Infant wide-field fundus photograph · 1240 by 1240 pixels: 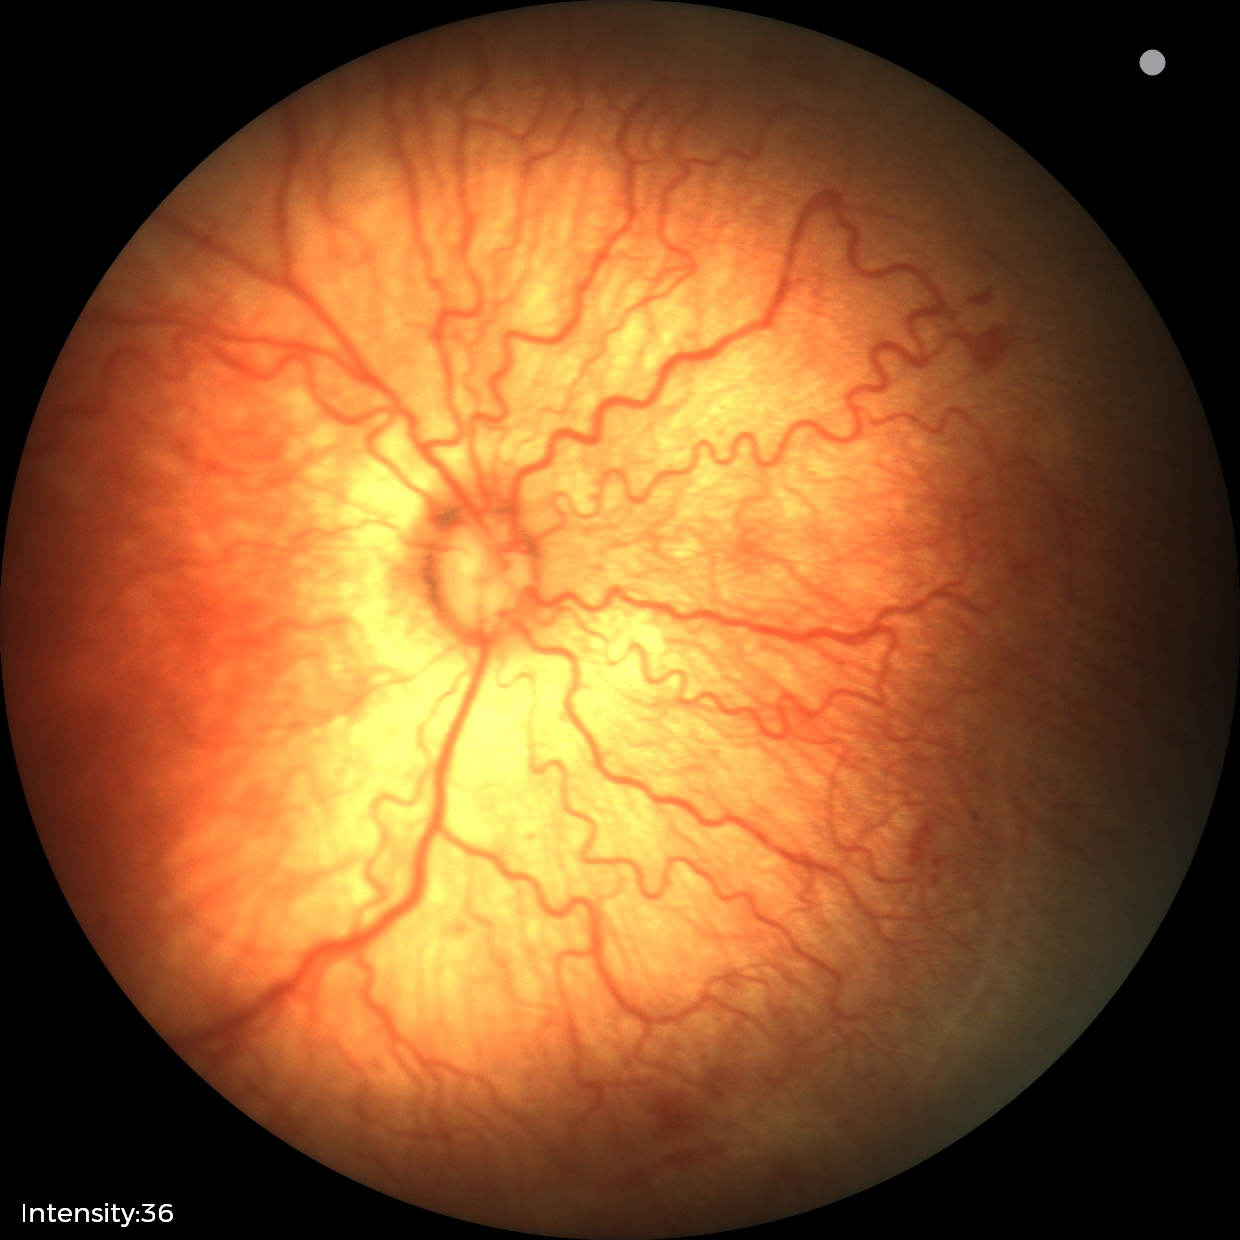 Series diagnosed as ROP stage 2.